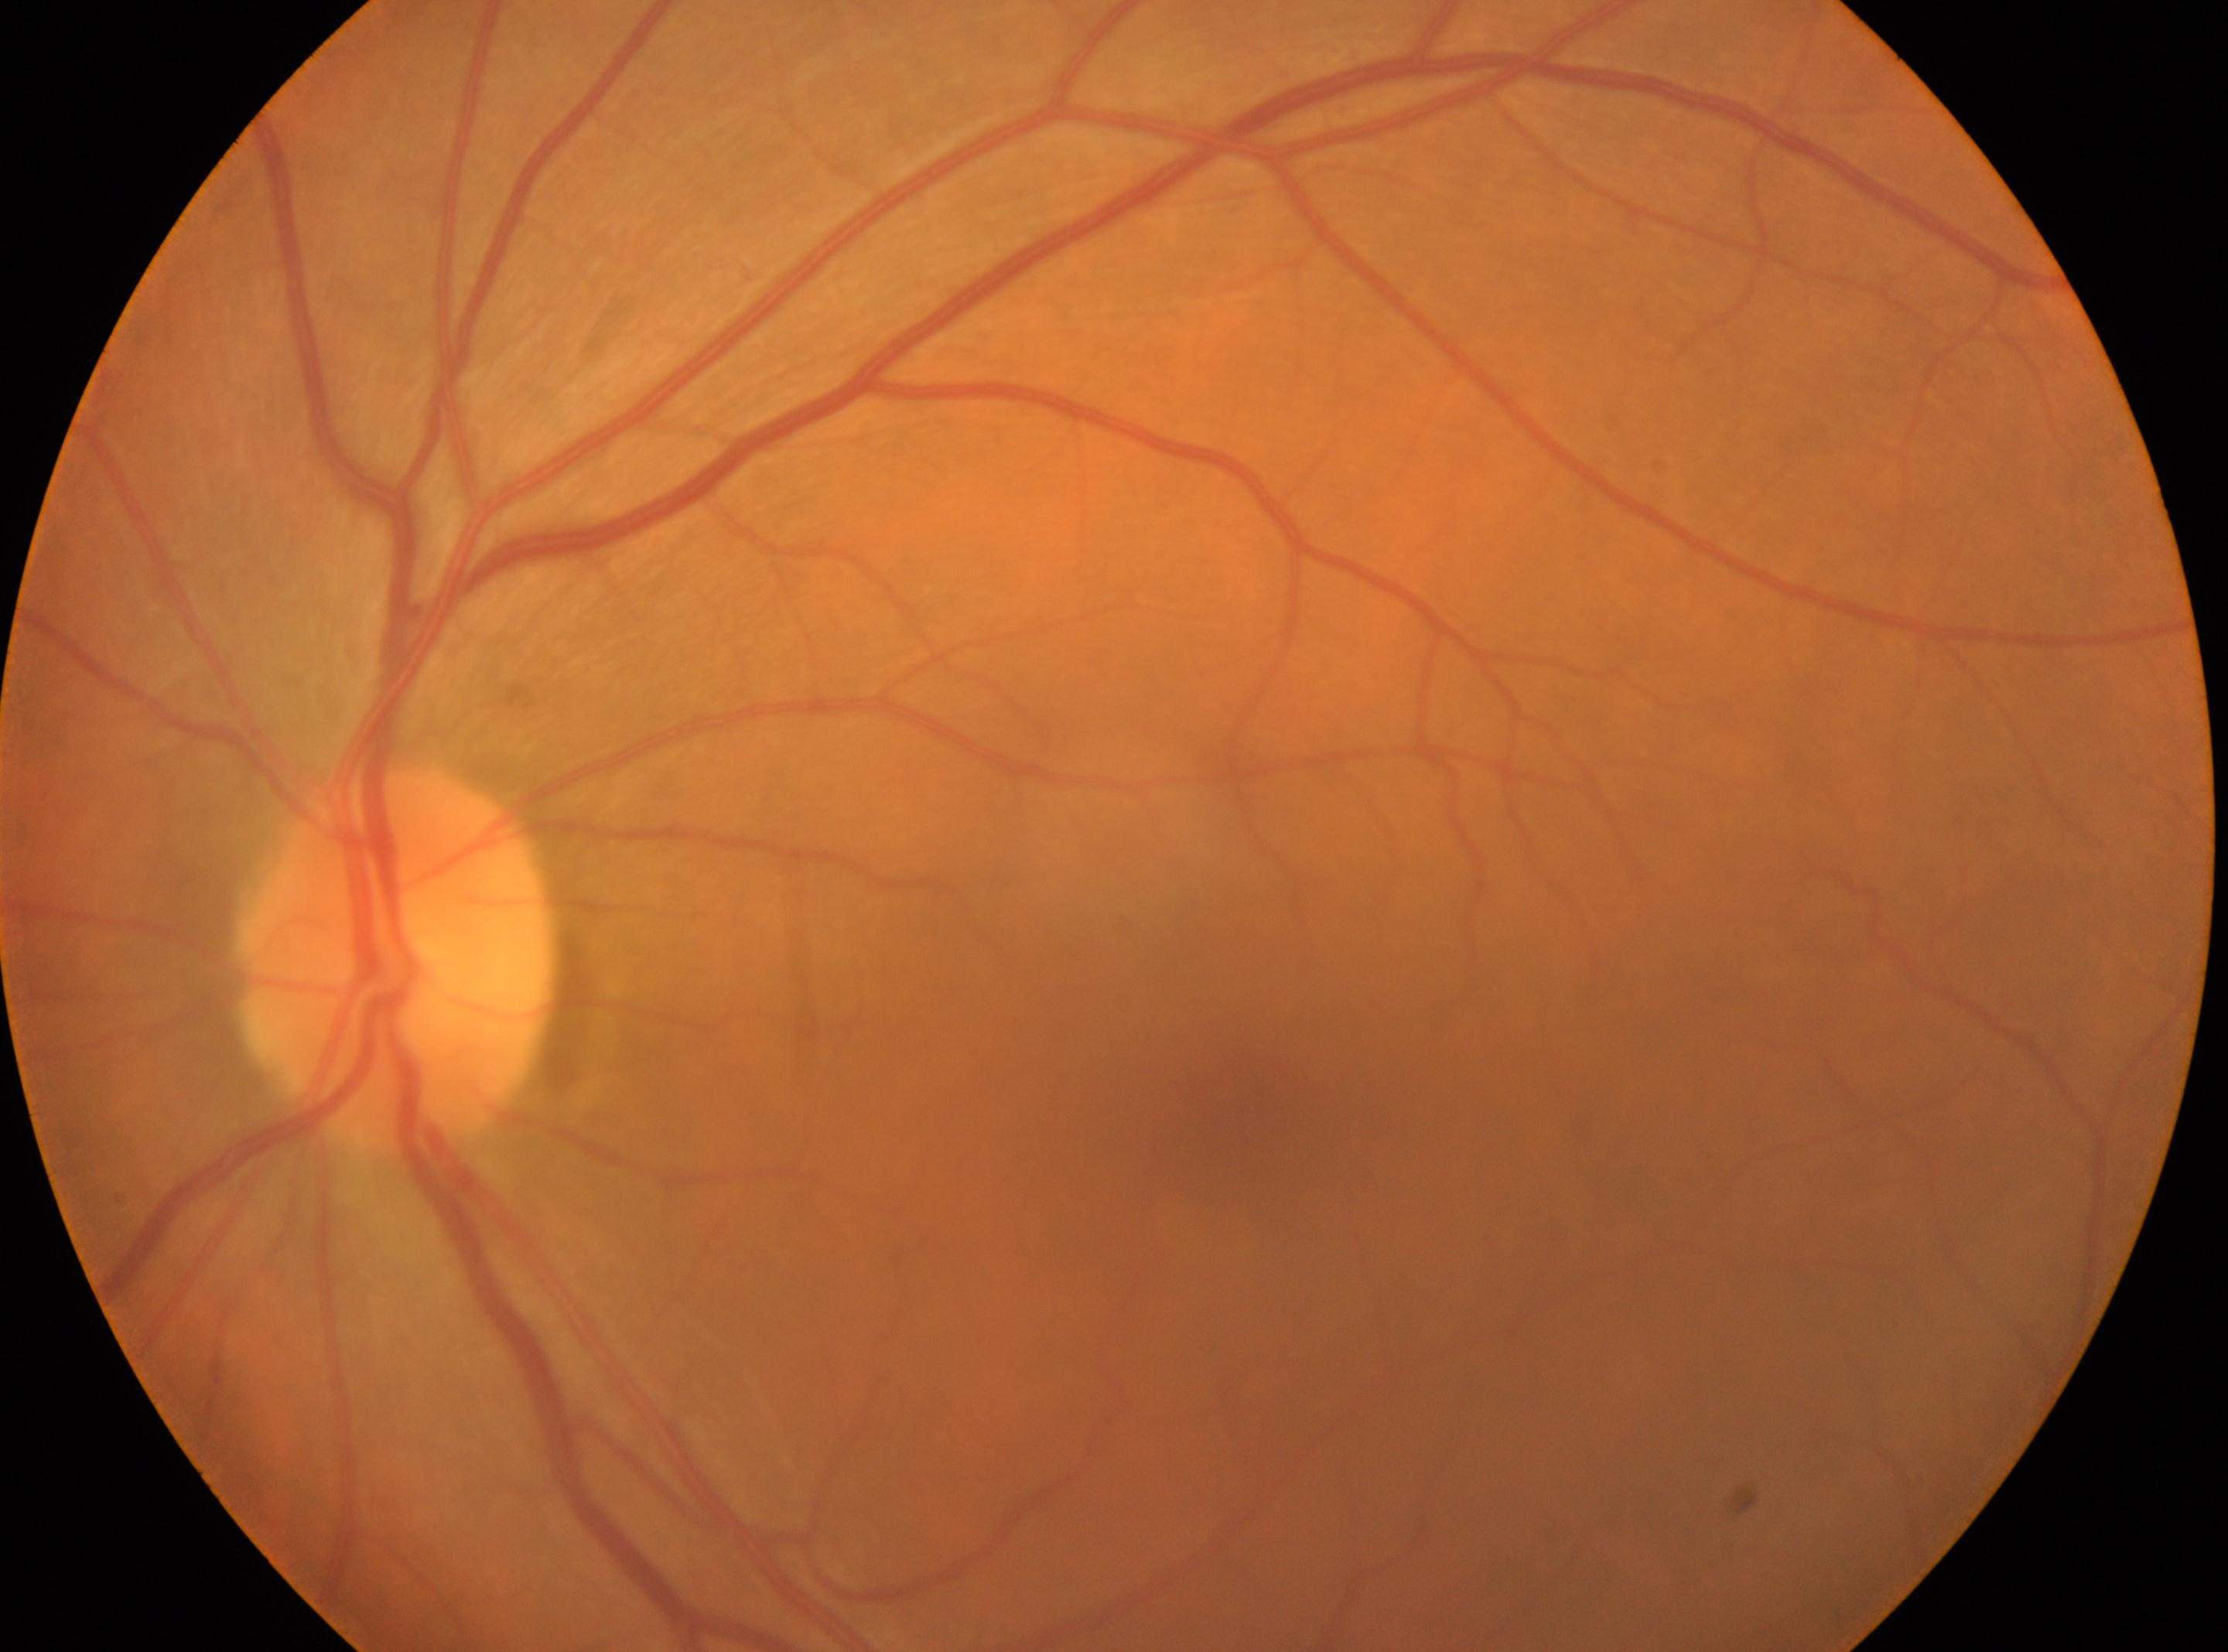
- laterality: left eye
- diabetic retinopathy: no apparent diabetic retinopathy (grade 0)
- optic nerve head: (x=393, y=959)
- fovea: (x=1235, y=1121)
- DR impression: No signs of diabetic retinopathy